45 degree fundus photograph · image size 848x848:
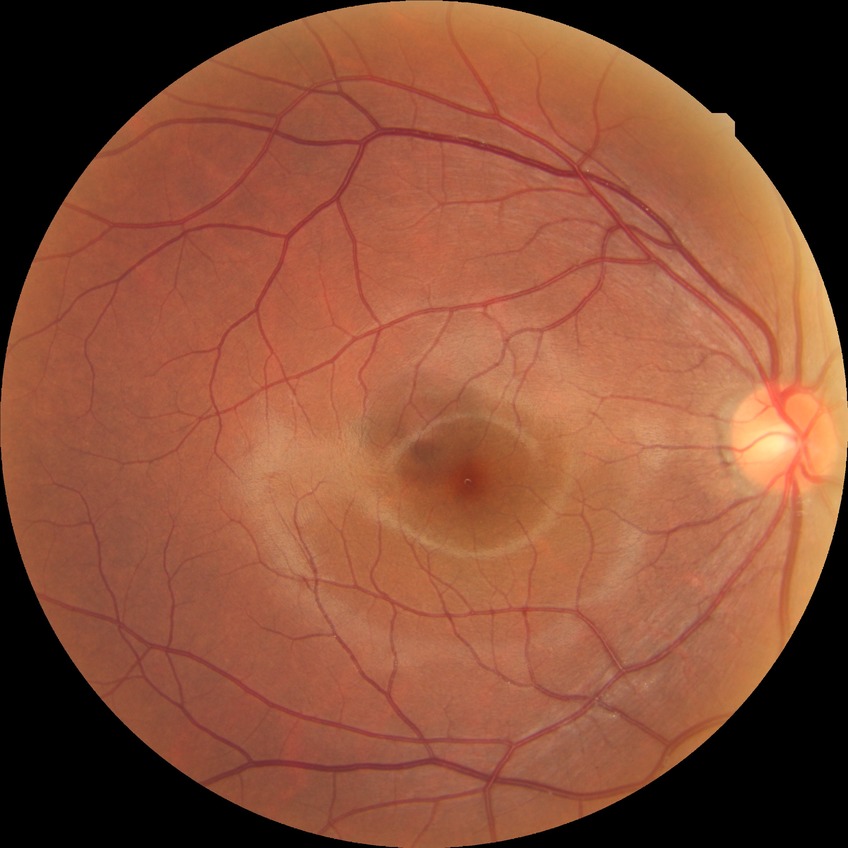 Retinopathy stage: no diabetic retinopathy.